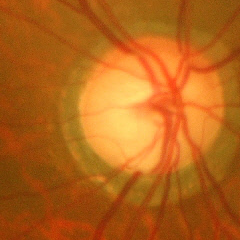
Advanced-stage glaucoma.
Diagnostic criteria: near-total cupping of the optic nerve head, with or without severe visual field loss within the central 10 degrees of fixation.